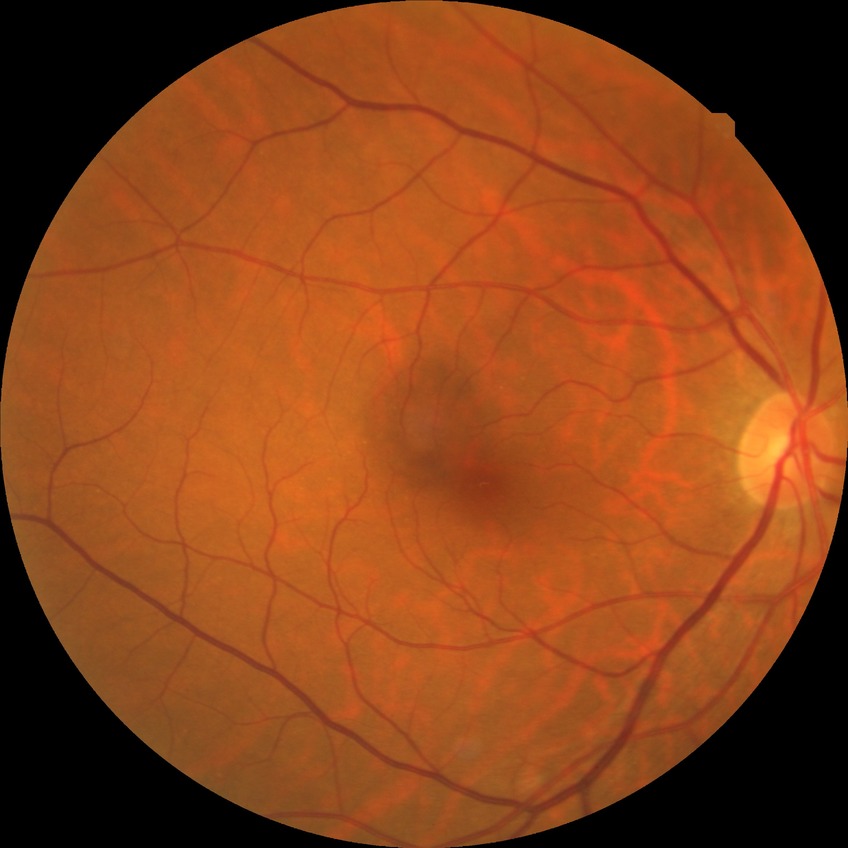
Diabetic retinopathy grade is no diabetic retinopathy.